Posterior pole photograph, 45 degree fundus photograph, NIDEK AFC-230, nonmydriatic:
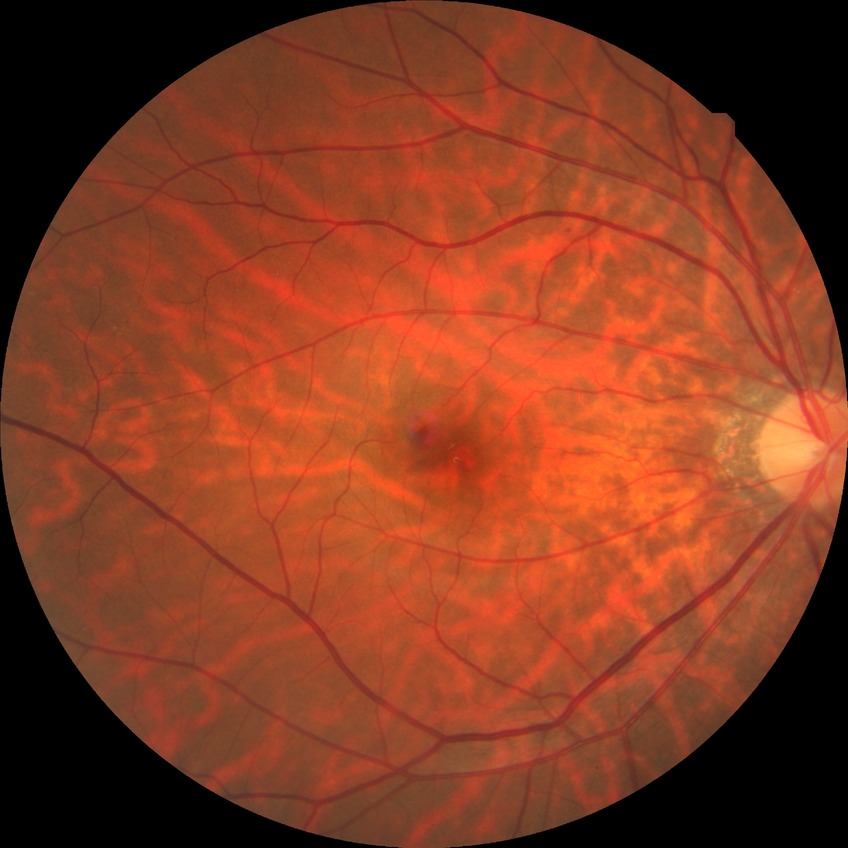 Diabetic retinopathy (DR) is NDR (no diabetic retinopathy).